Infant wide-field fundus photograph
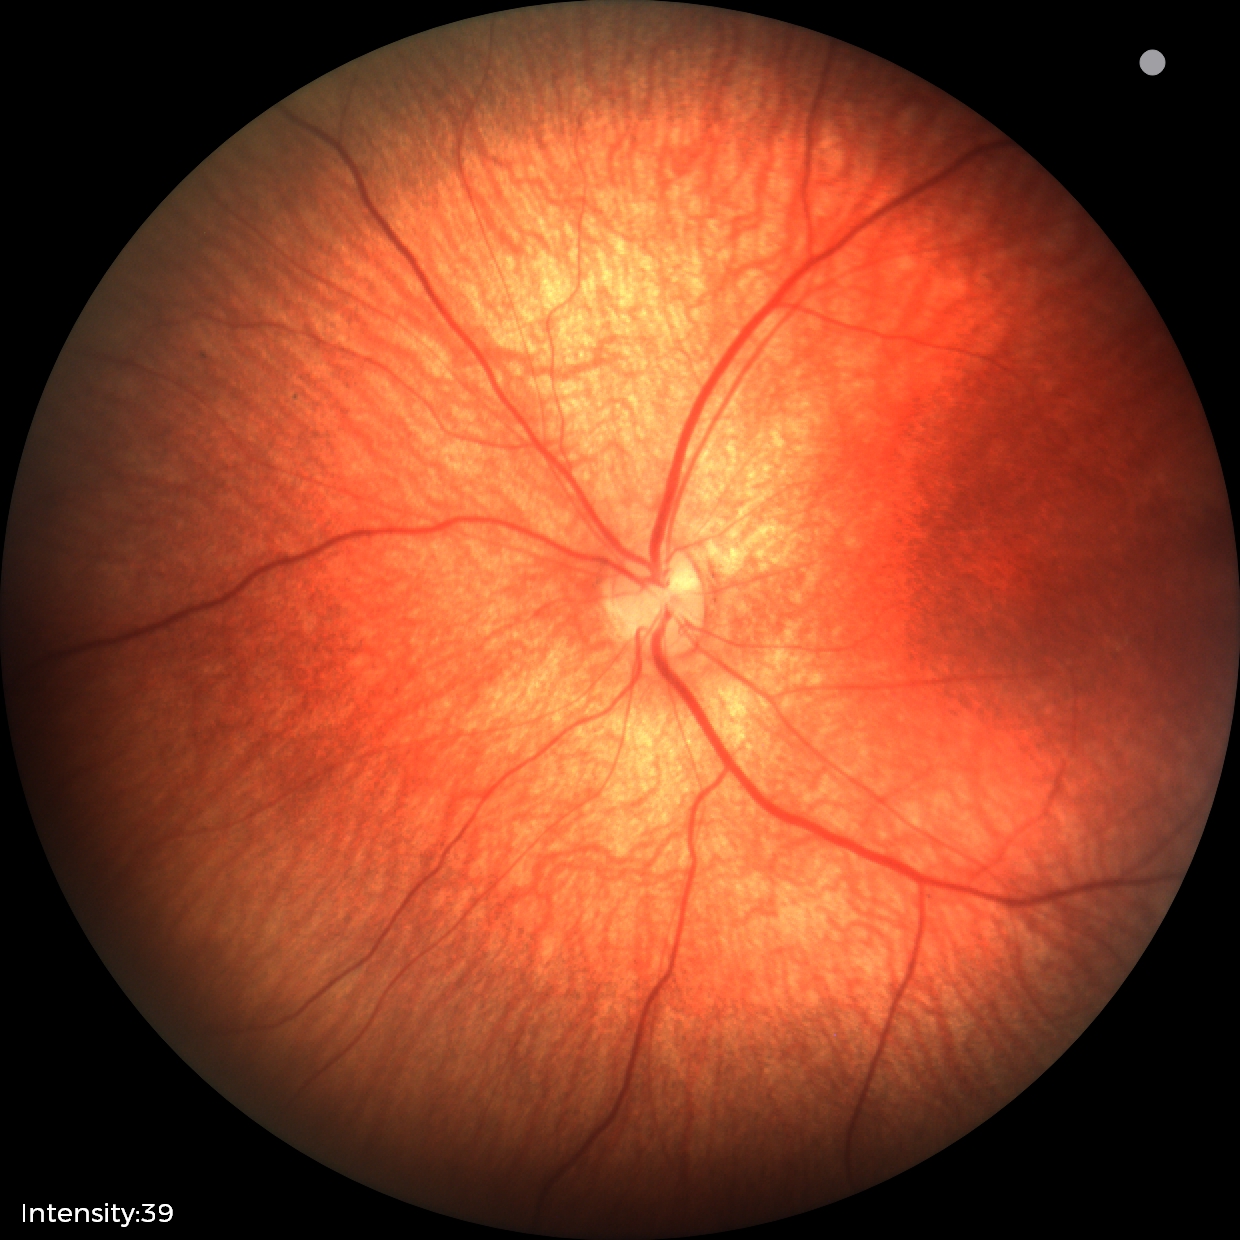

Assessment = retinal hemorrhages.